45-degree field of view:
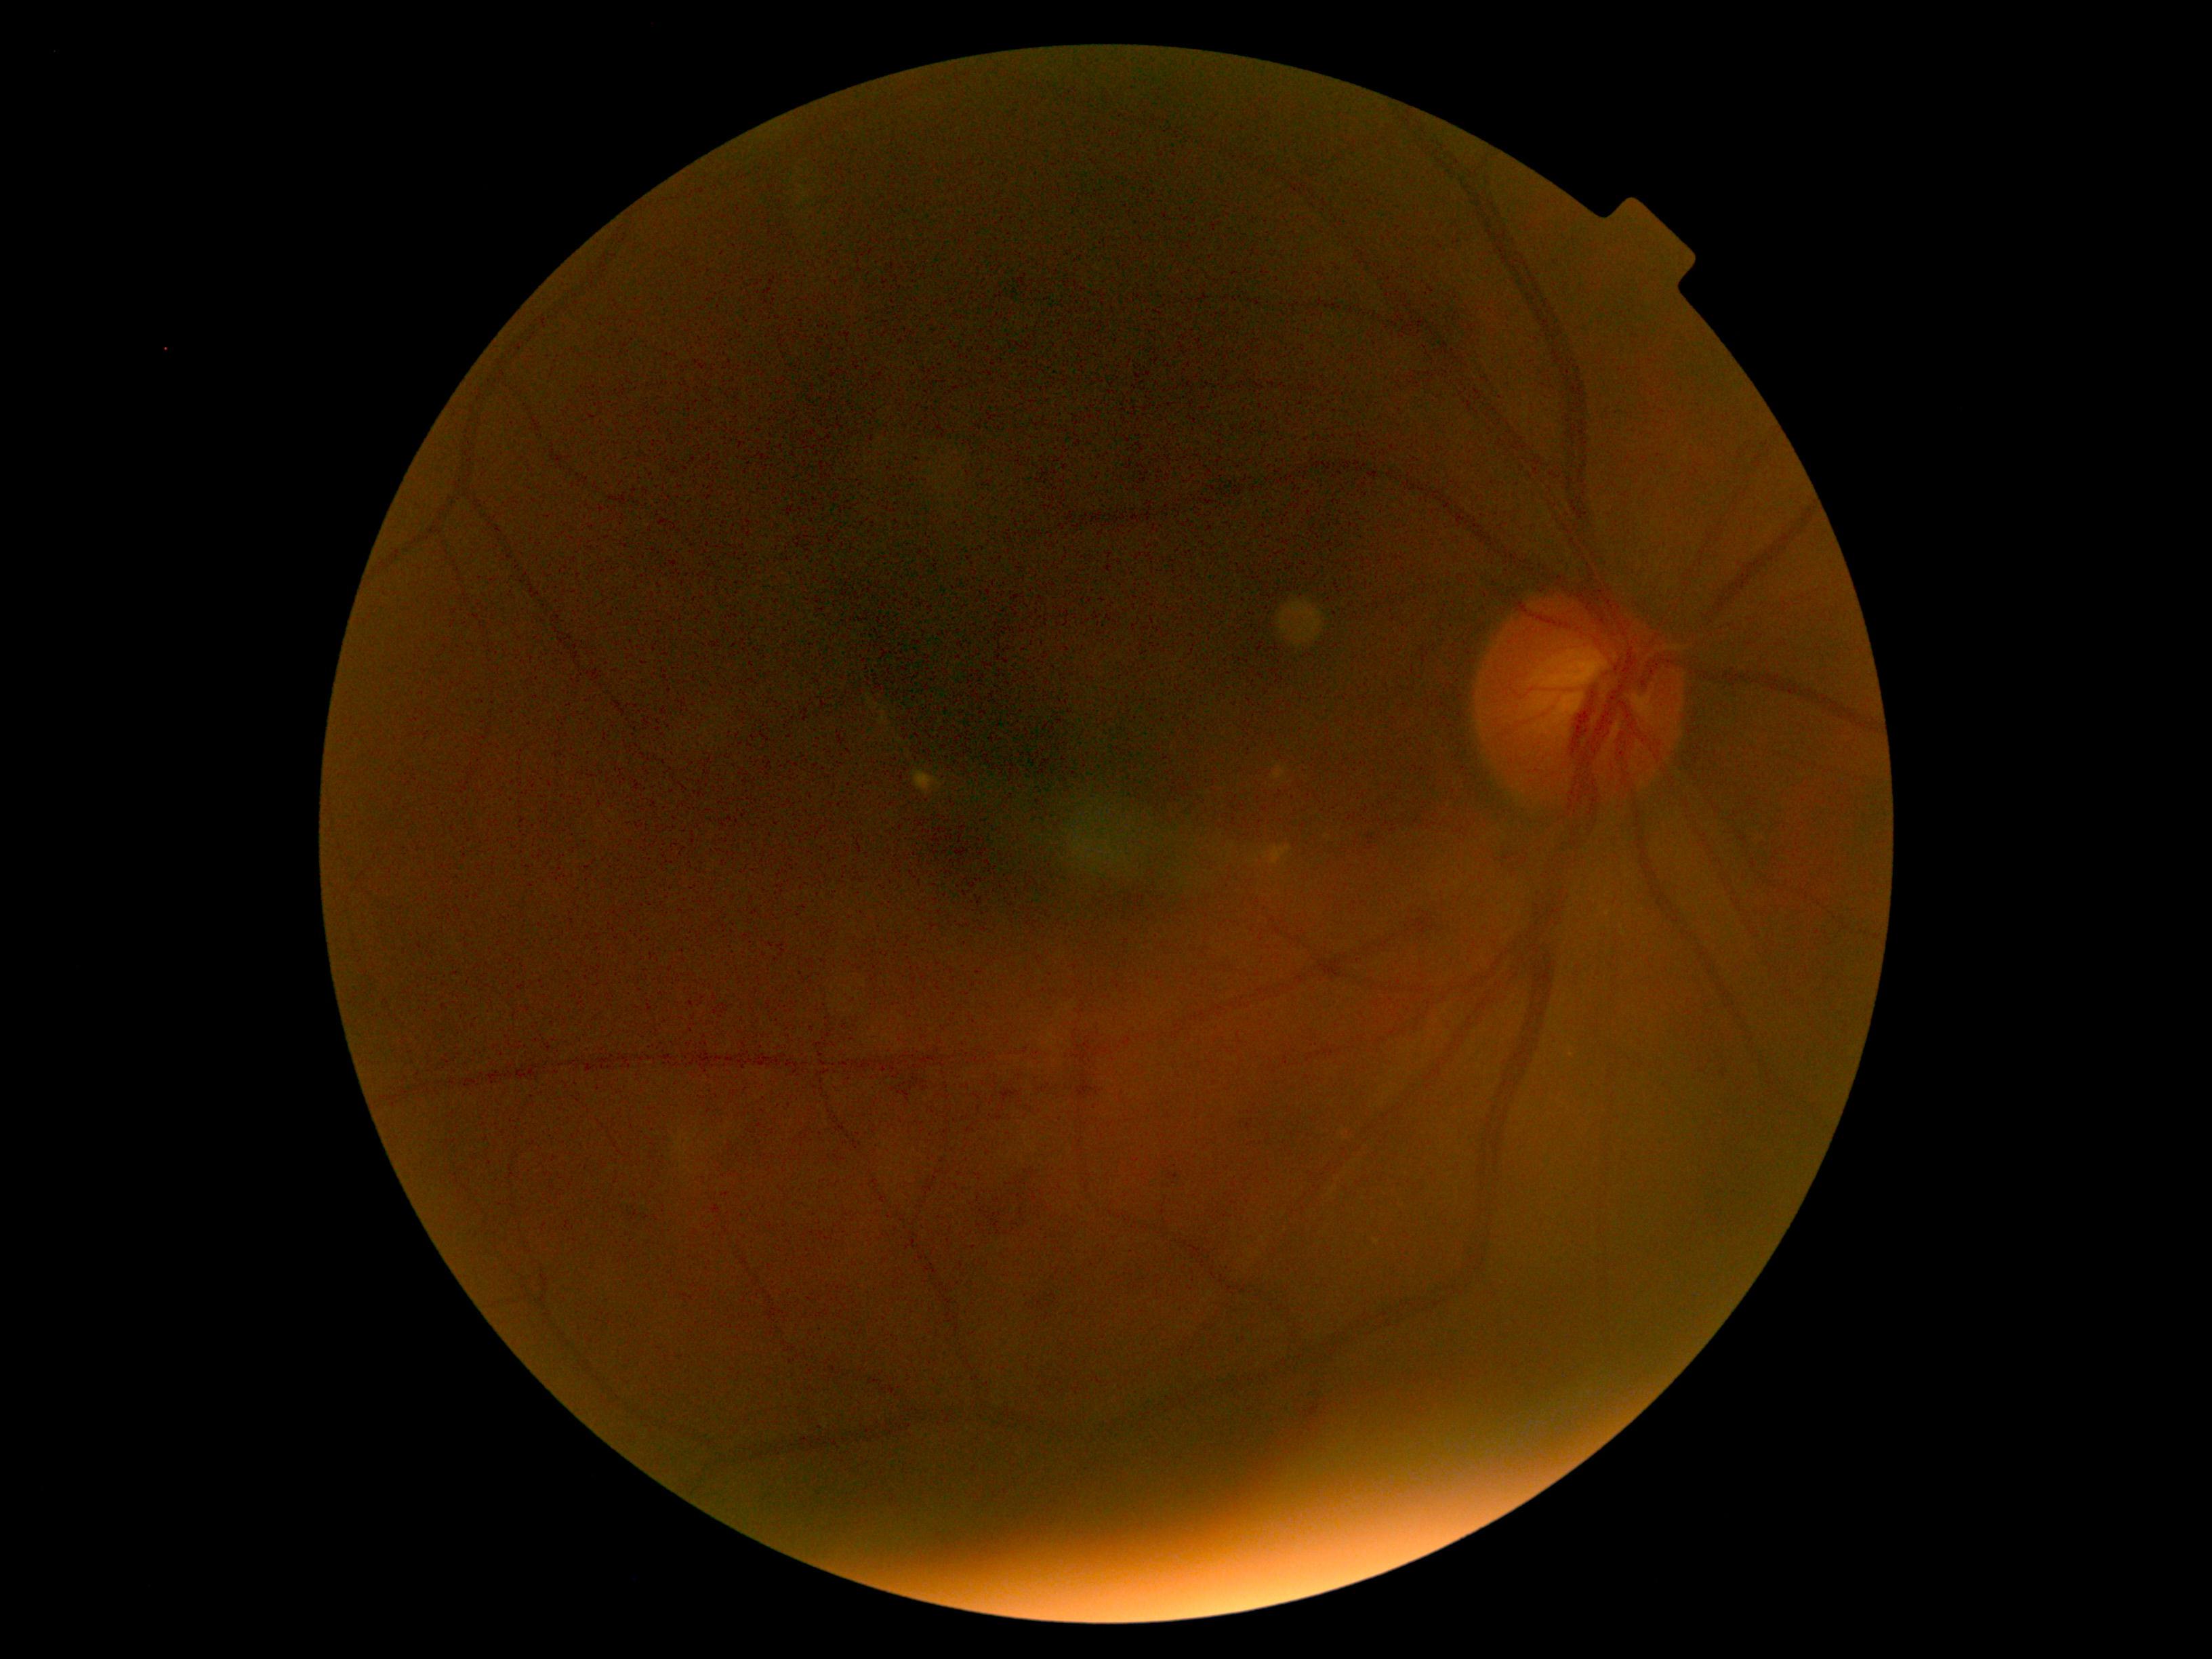
DR@2/4.